Modified Davis grading; NIDEK AFC-230 fundus camera; FOV: 45 degrees; image size 848x848.
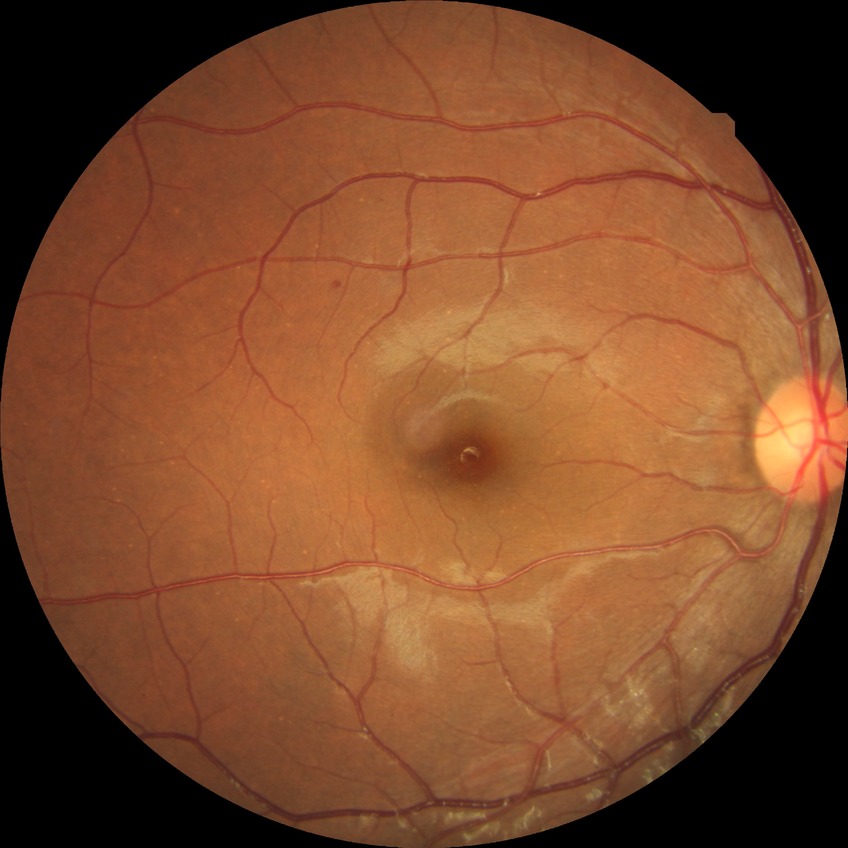 retinopathy stage = simple diabetic retinopathy; DR class = non-proliferative diabetic retinopathy.